Color fundus photograph from a handheld portable camera — 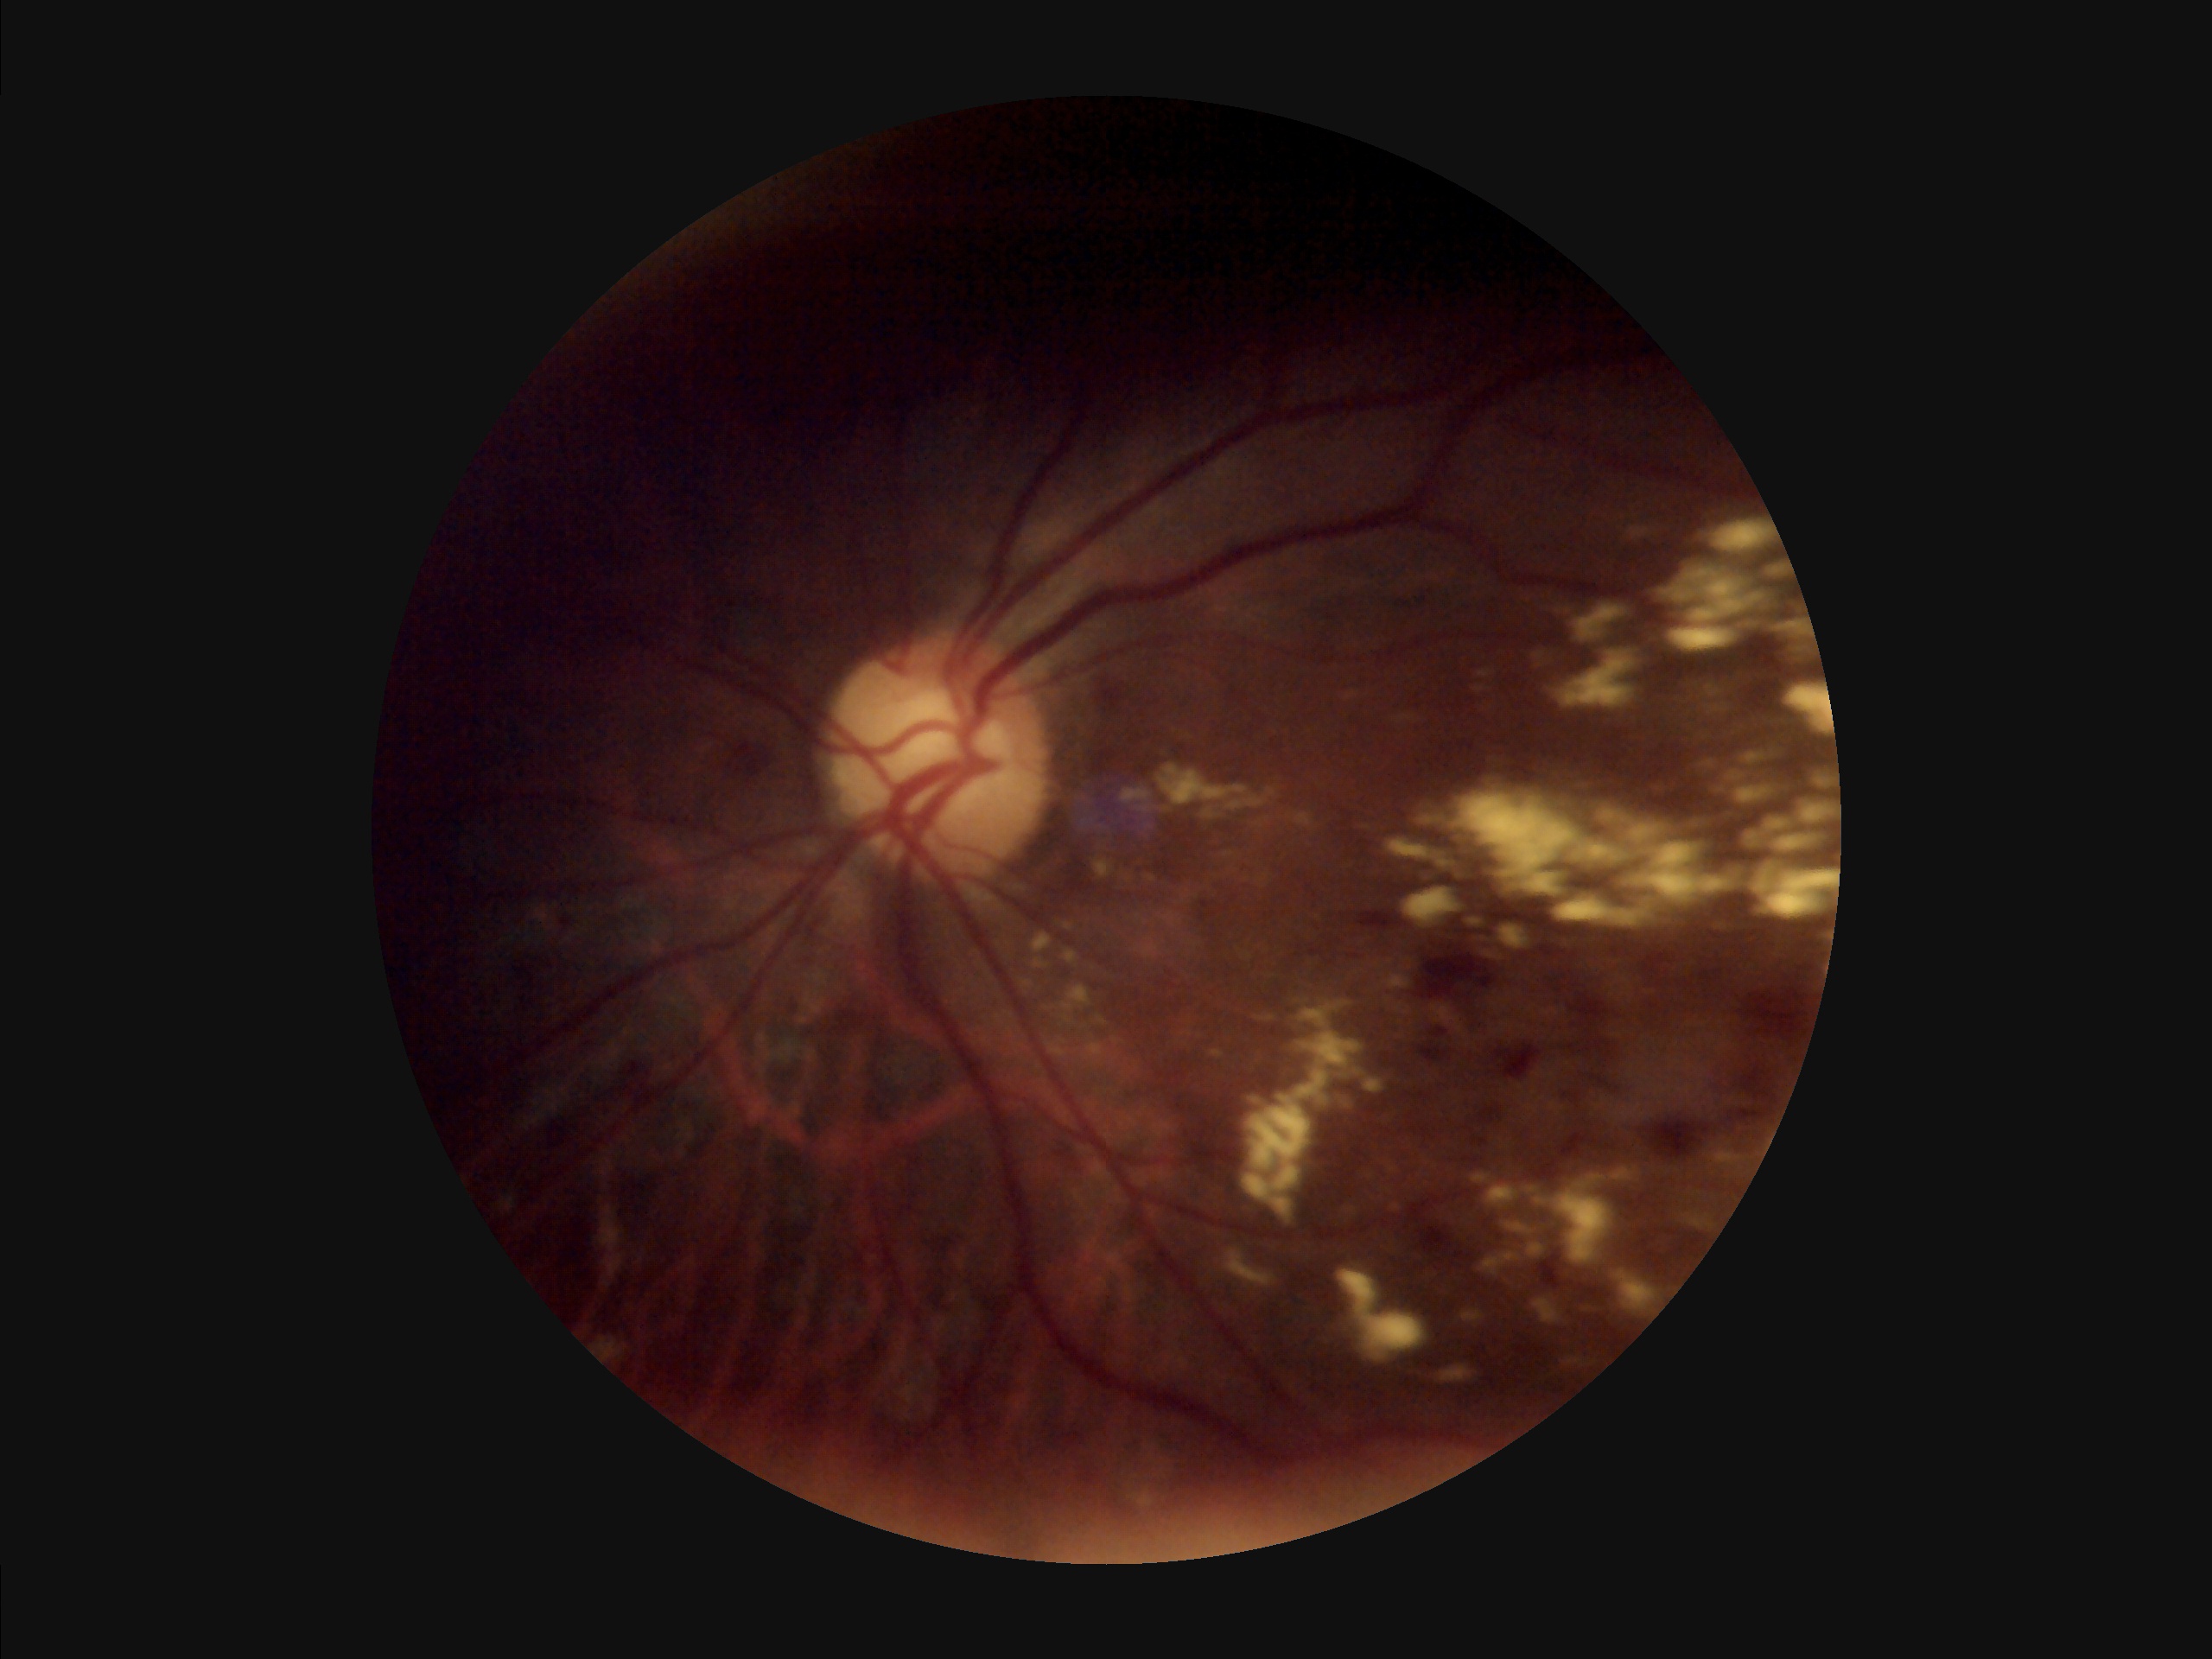
Quality grading: focus: reduced; overall: inadequate; illumination/color: poor; contrast: poor.